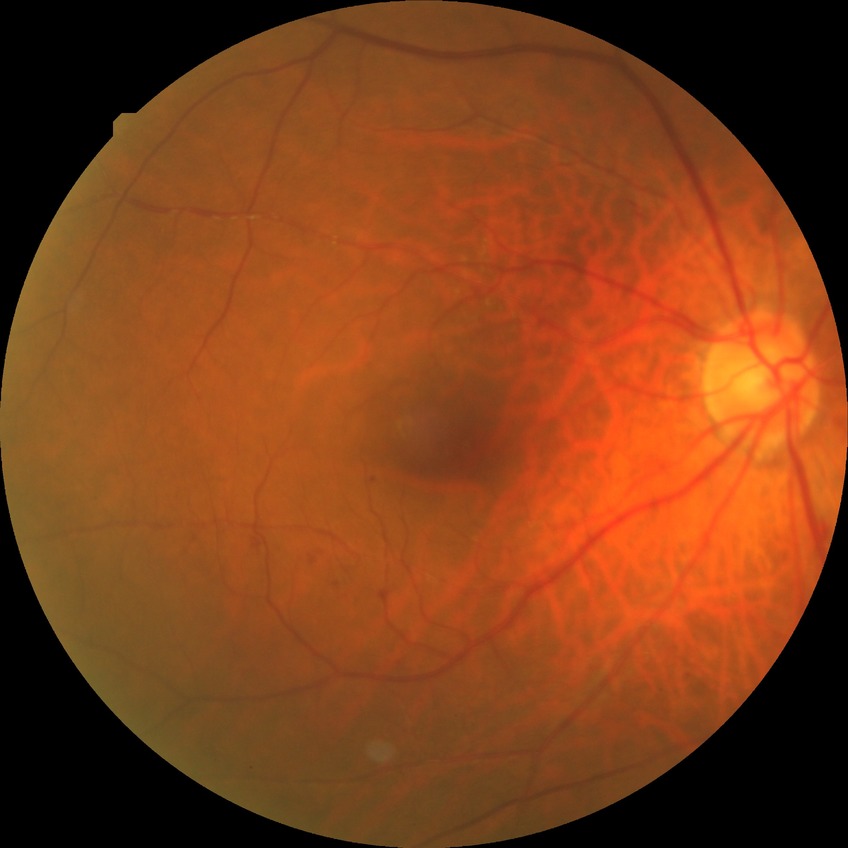
DR class: non-proliferative diabetic retinopathy.
Davis stage is SDR.